Color fundus image: 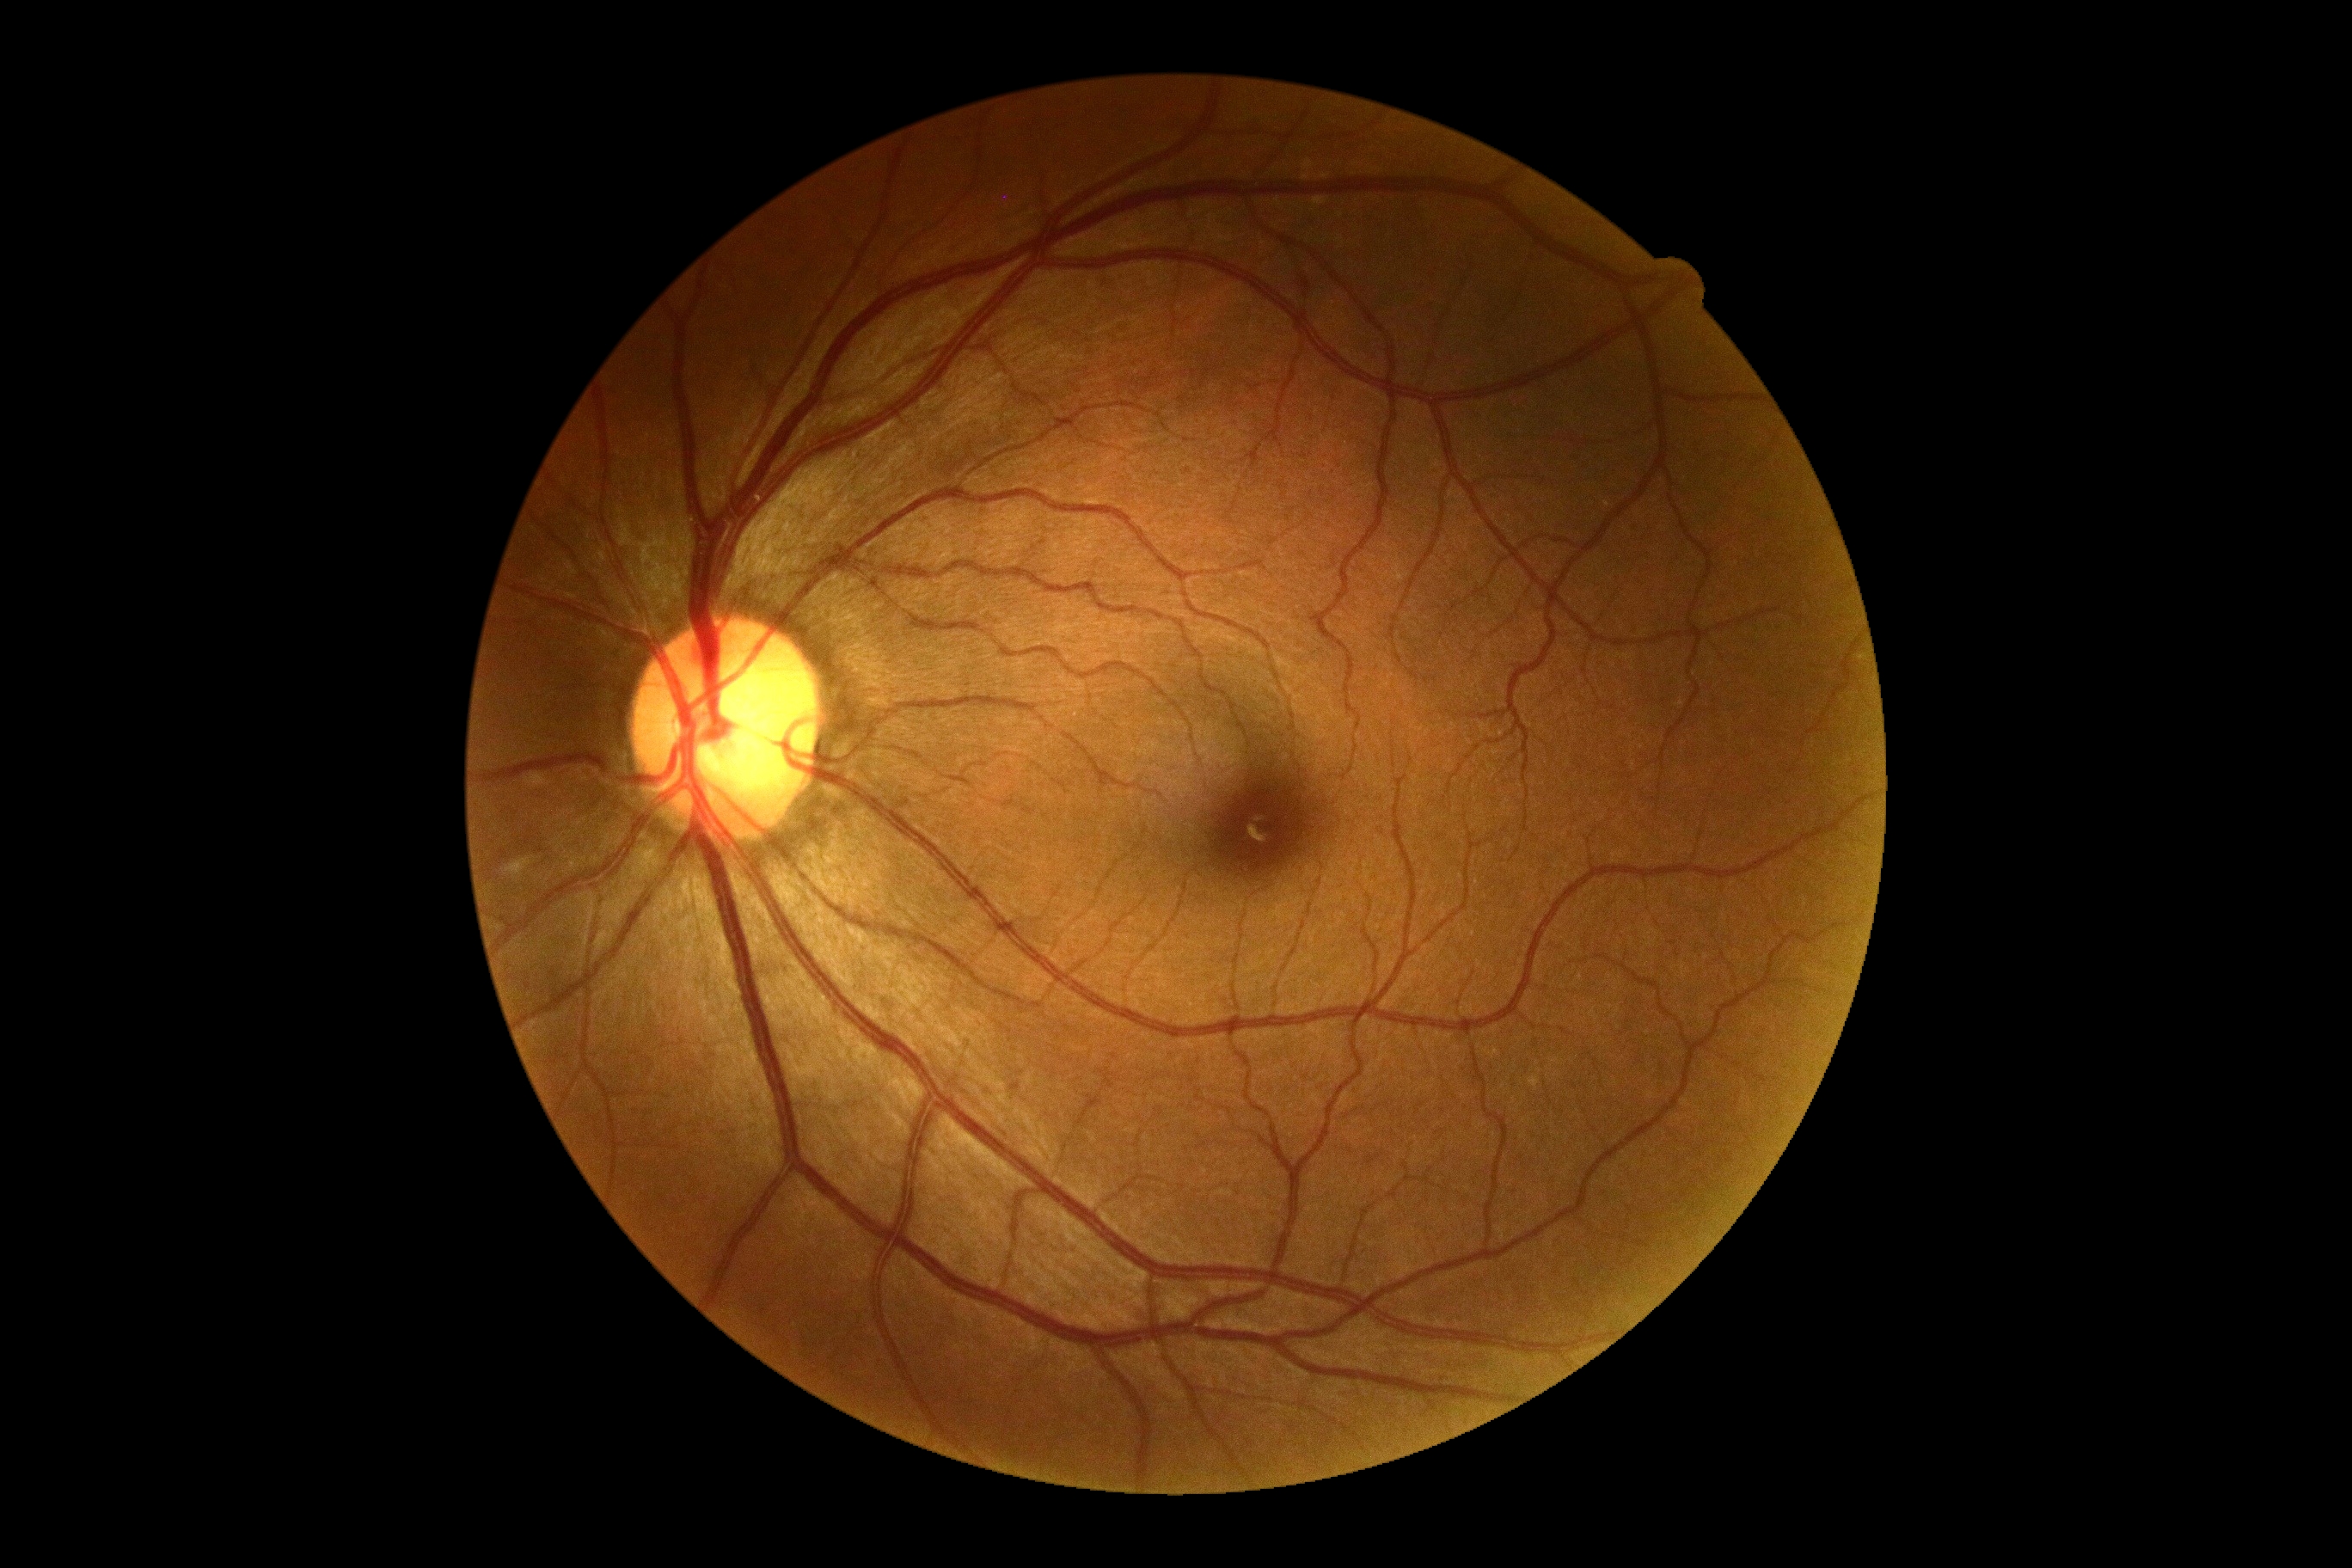

DR: 2/4.